45° FOV · DR severity per modified Davis staging · no pharmacologic dilation — 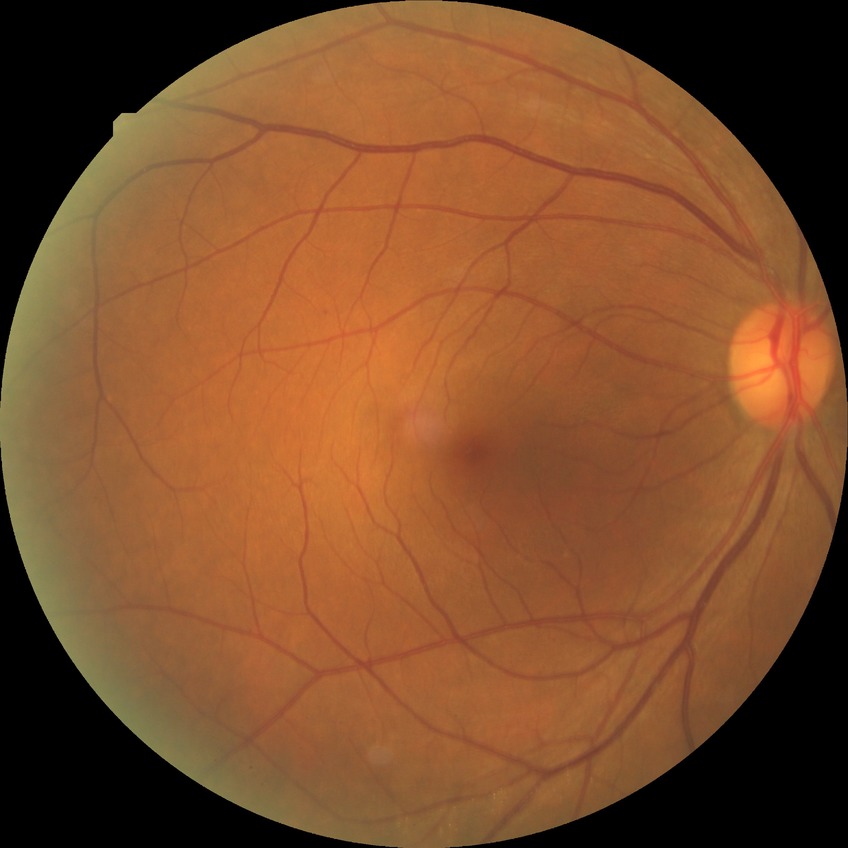
DR severity is PPDR.